1380x1382, fundus photo, 45° field of view:
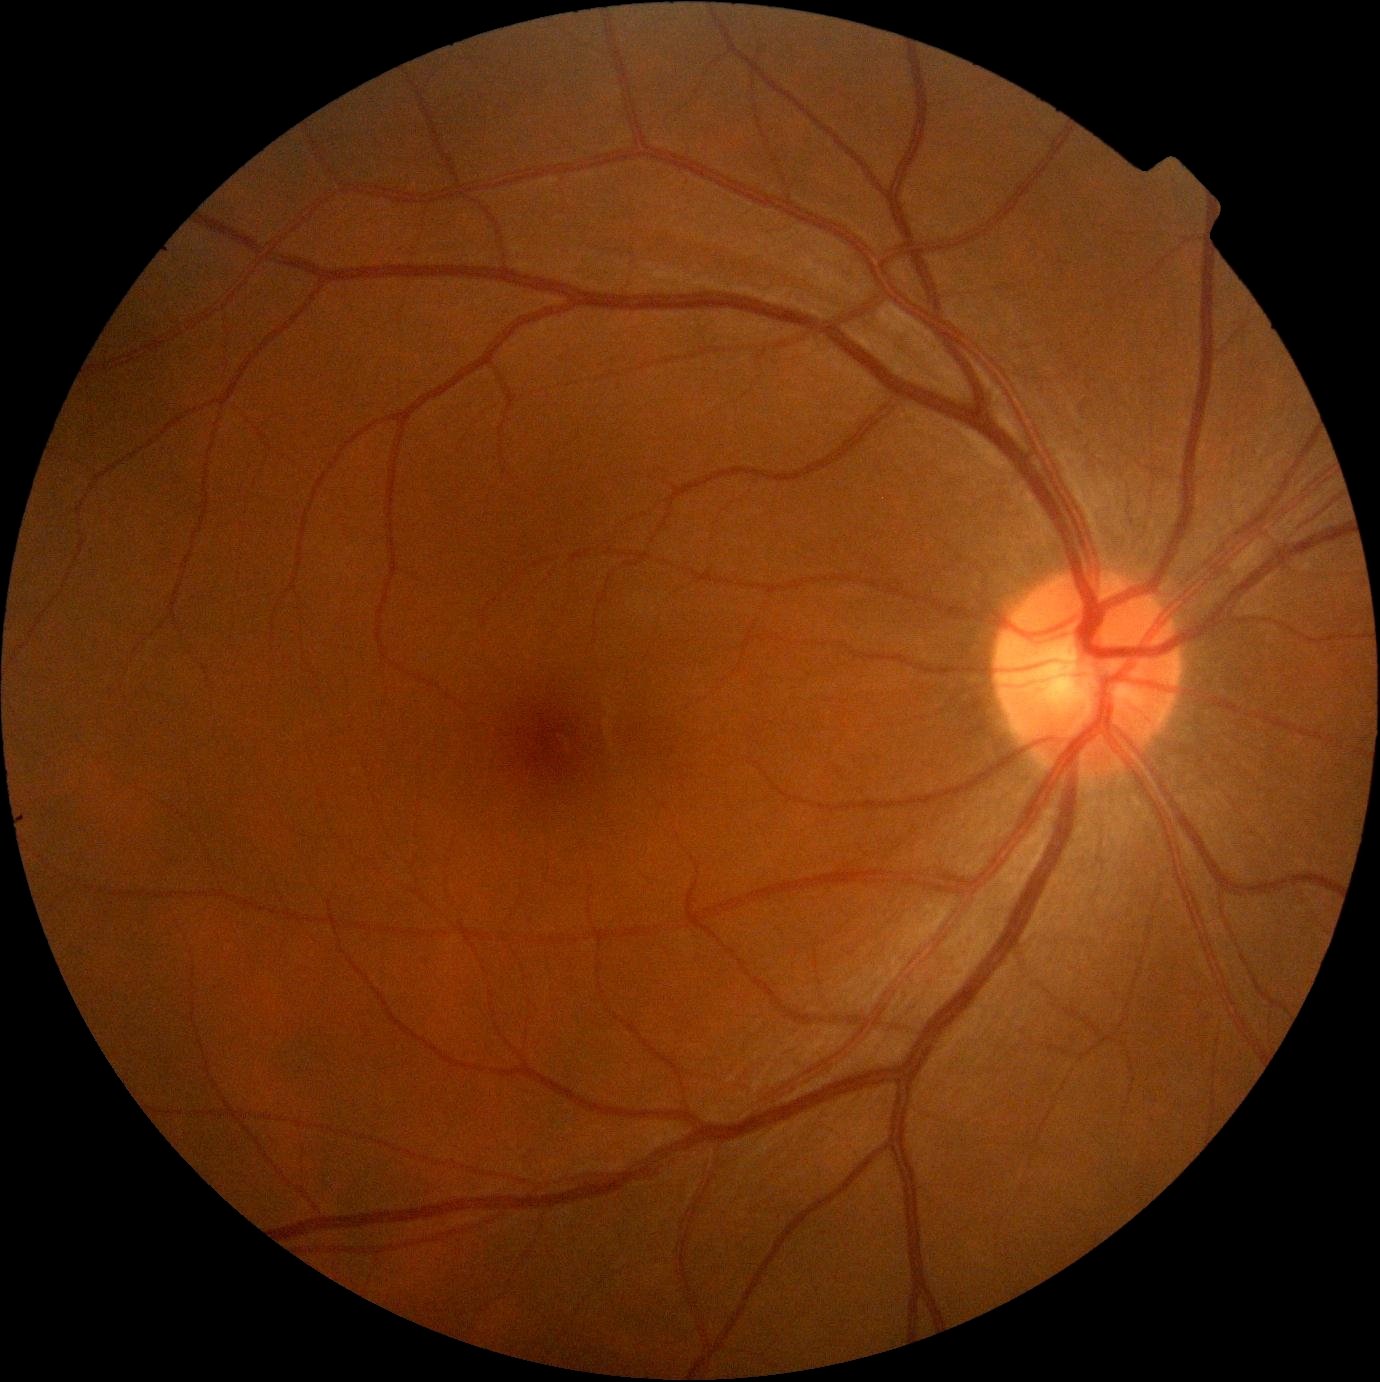

Diabetic retinopathy (DR): 0.